Optic nerve head crop · 240x240.
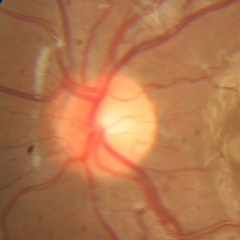

No glaucomatous changes.